Fundus photo
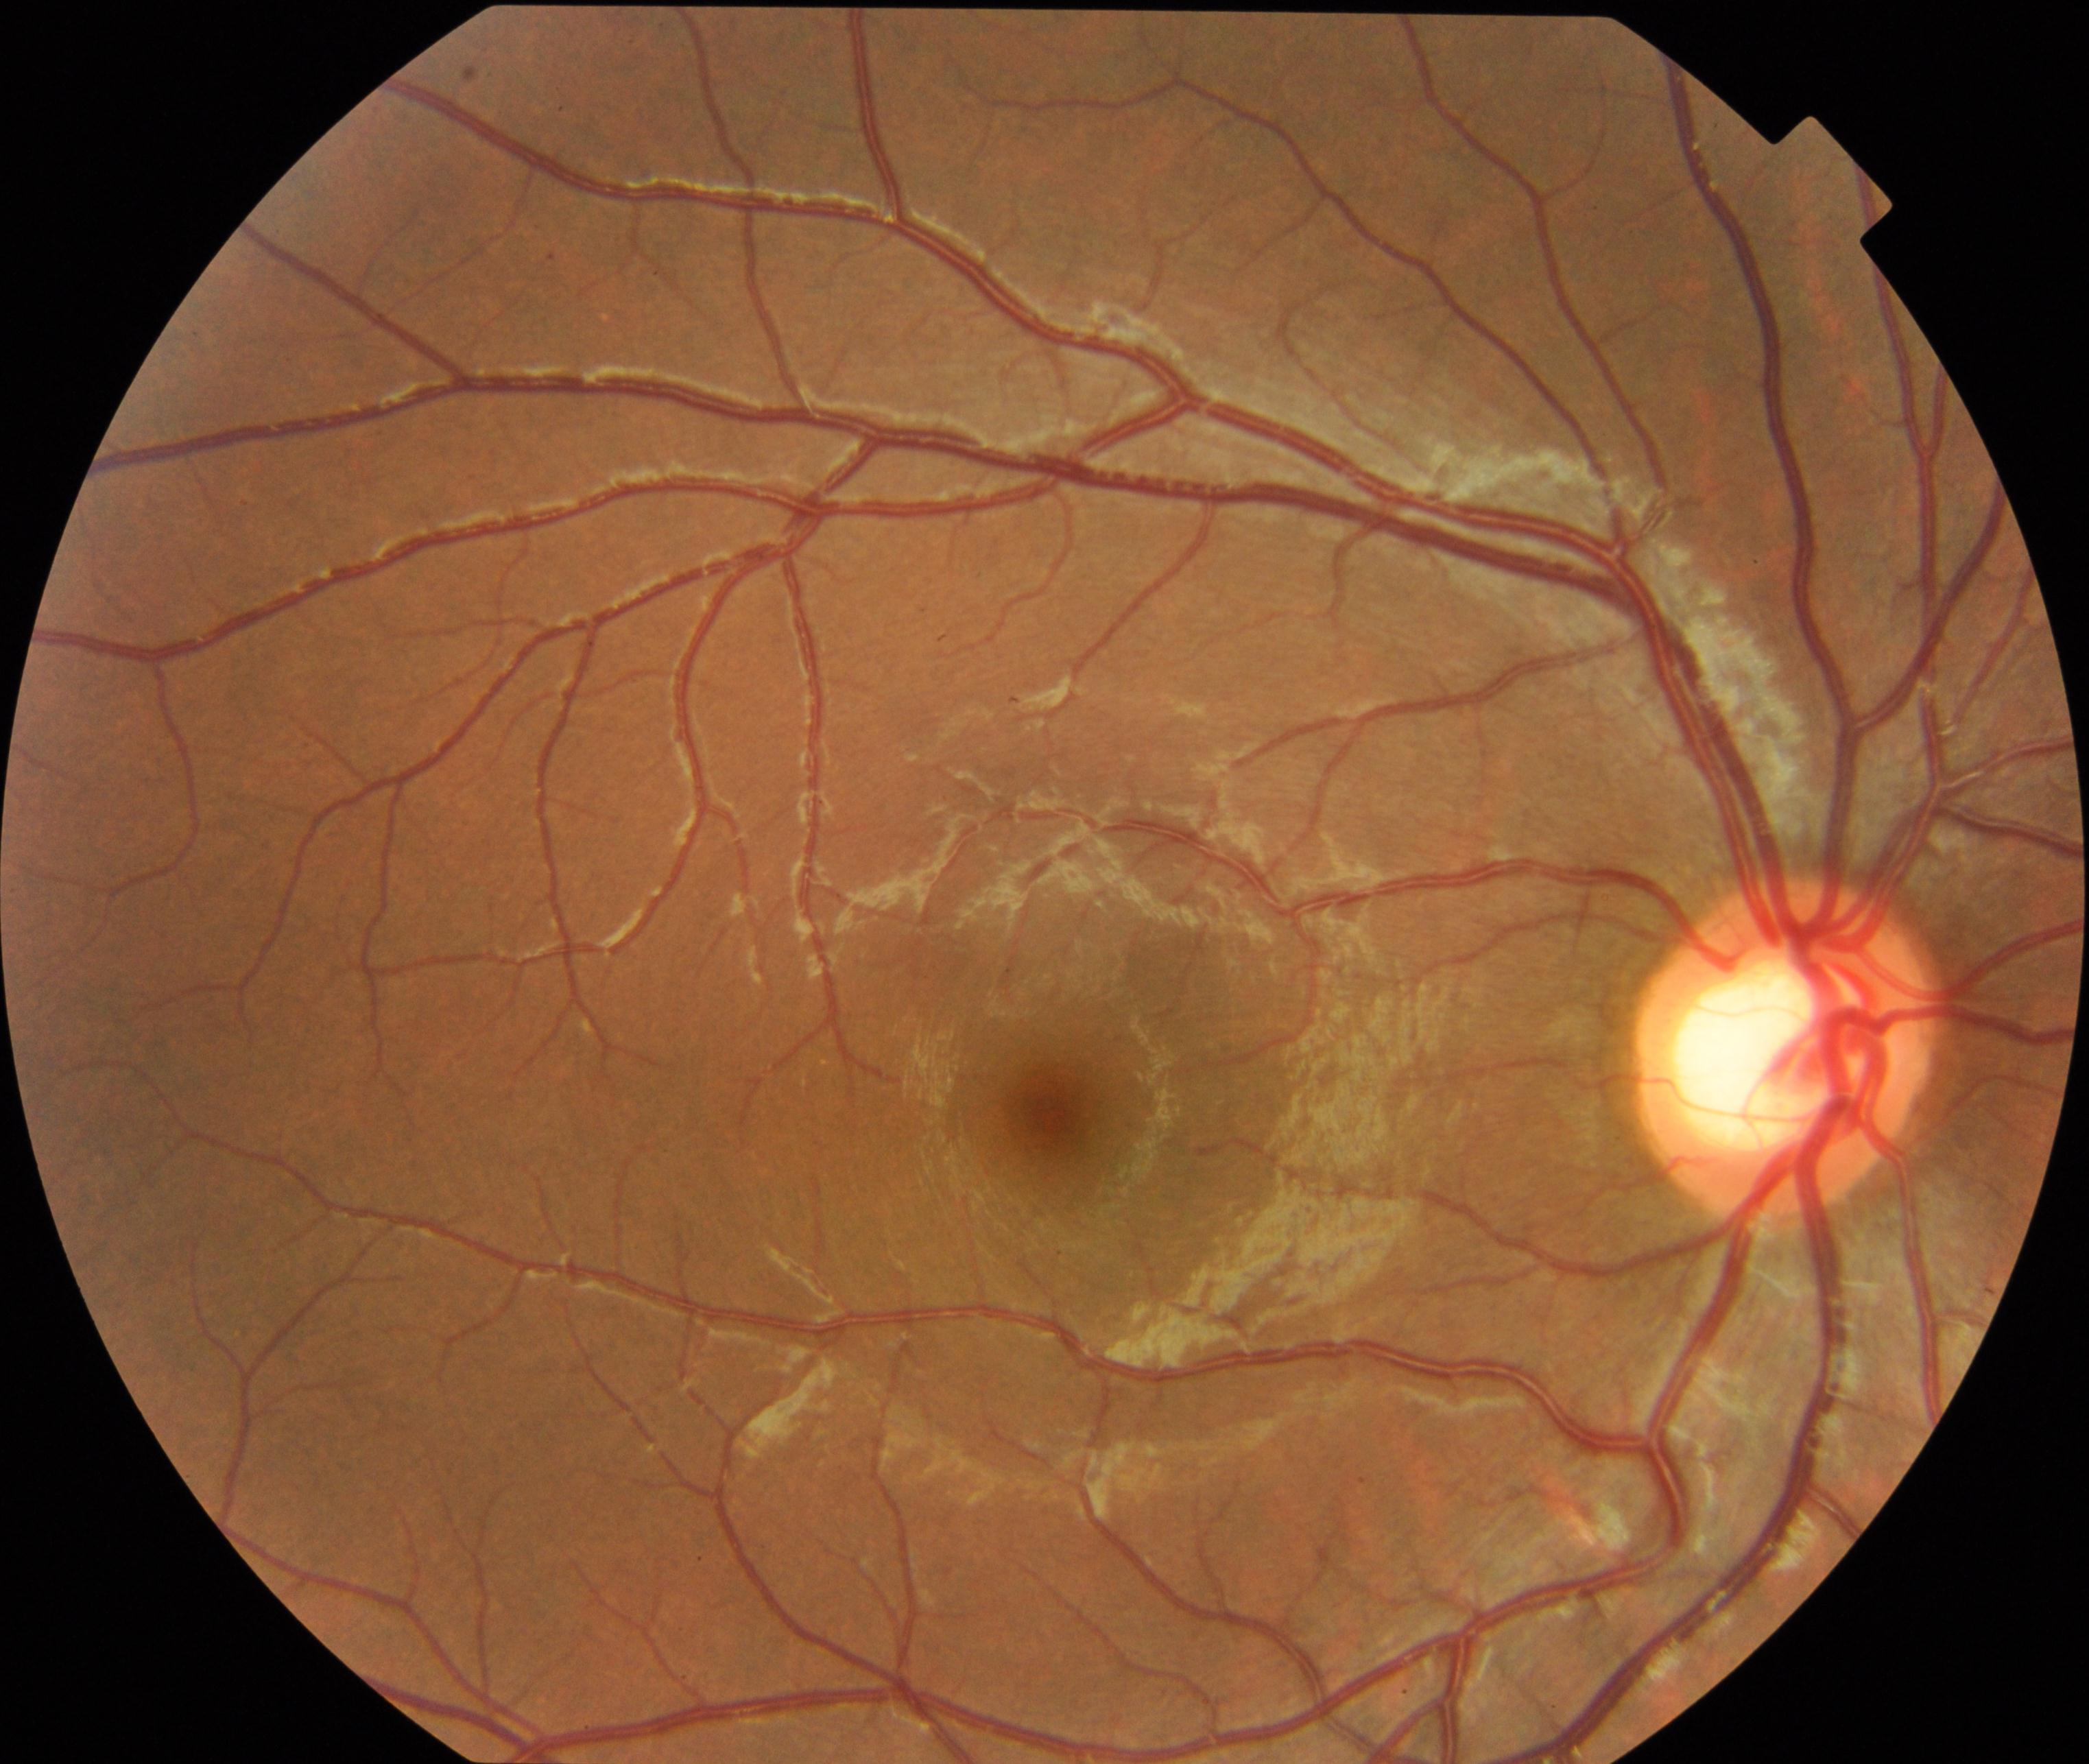 There is evidence of large optic cup.